45-degree field of view, retinal fundus photograph.
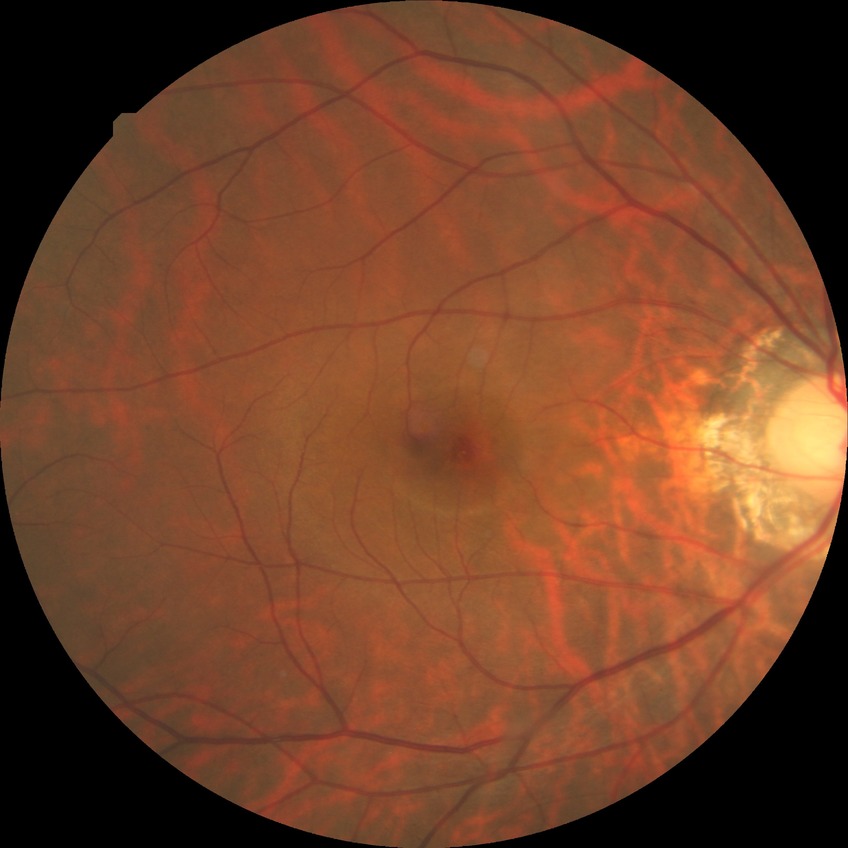

Davis grade: NDR.